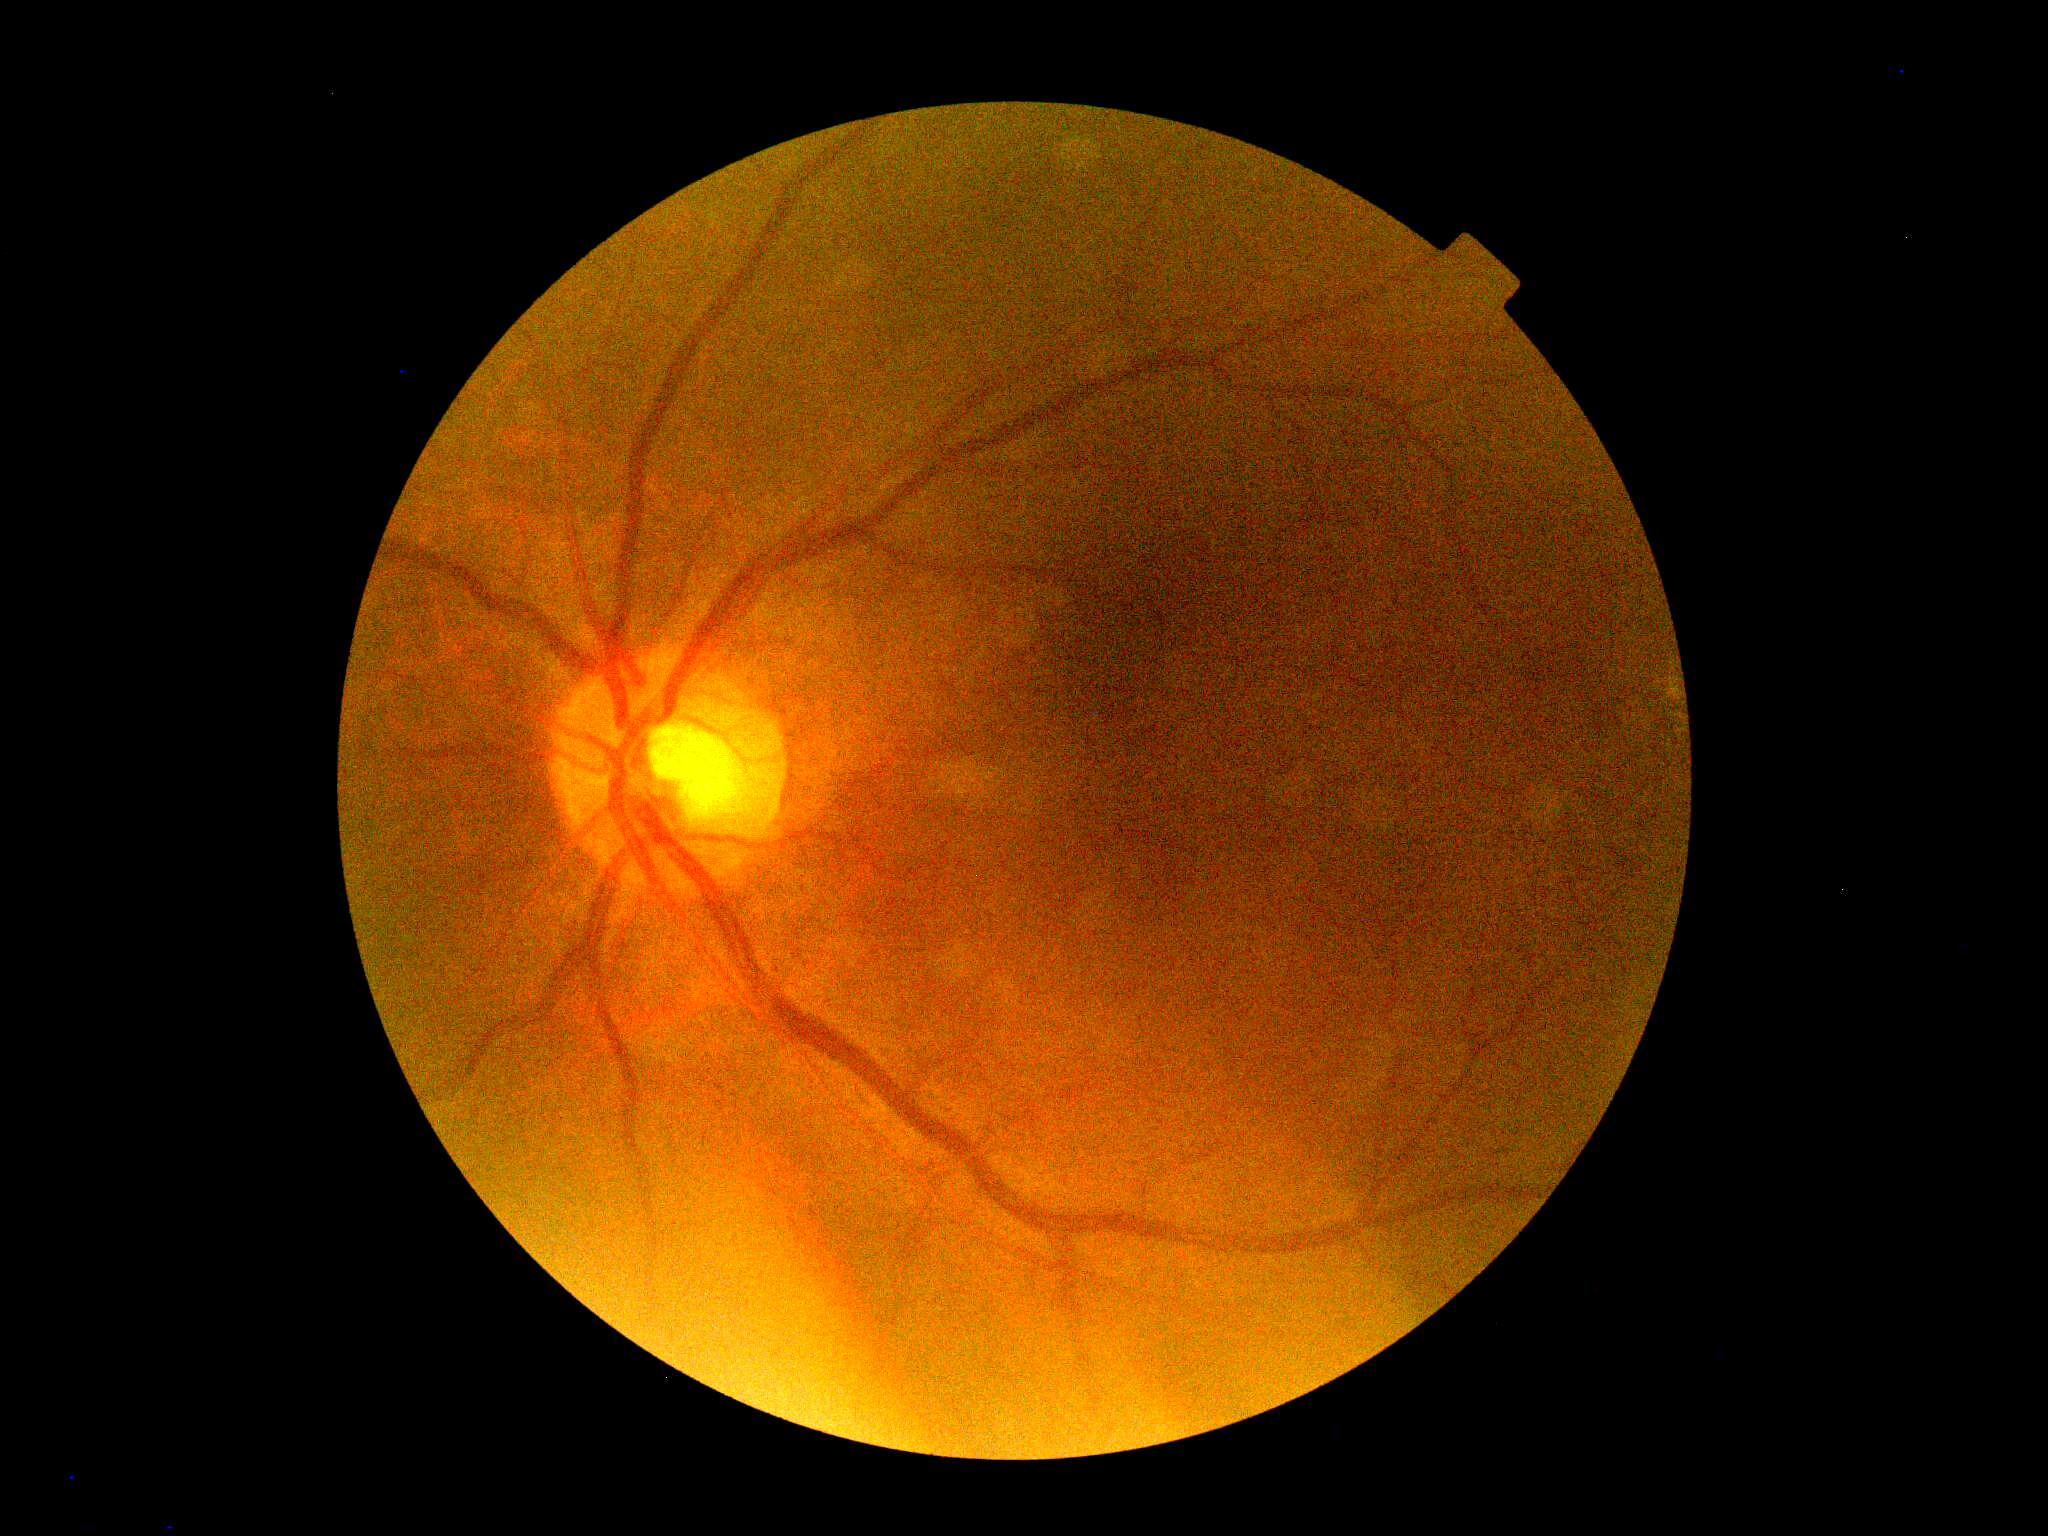

DR grade=0, DR impression=no apparent DR.